Color fundus image
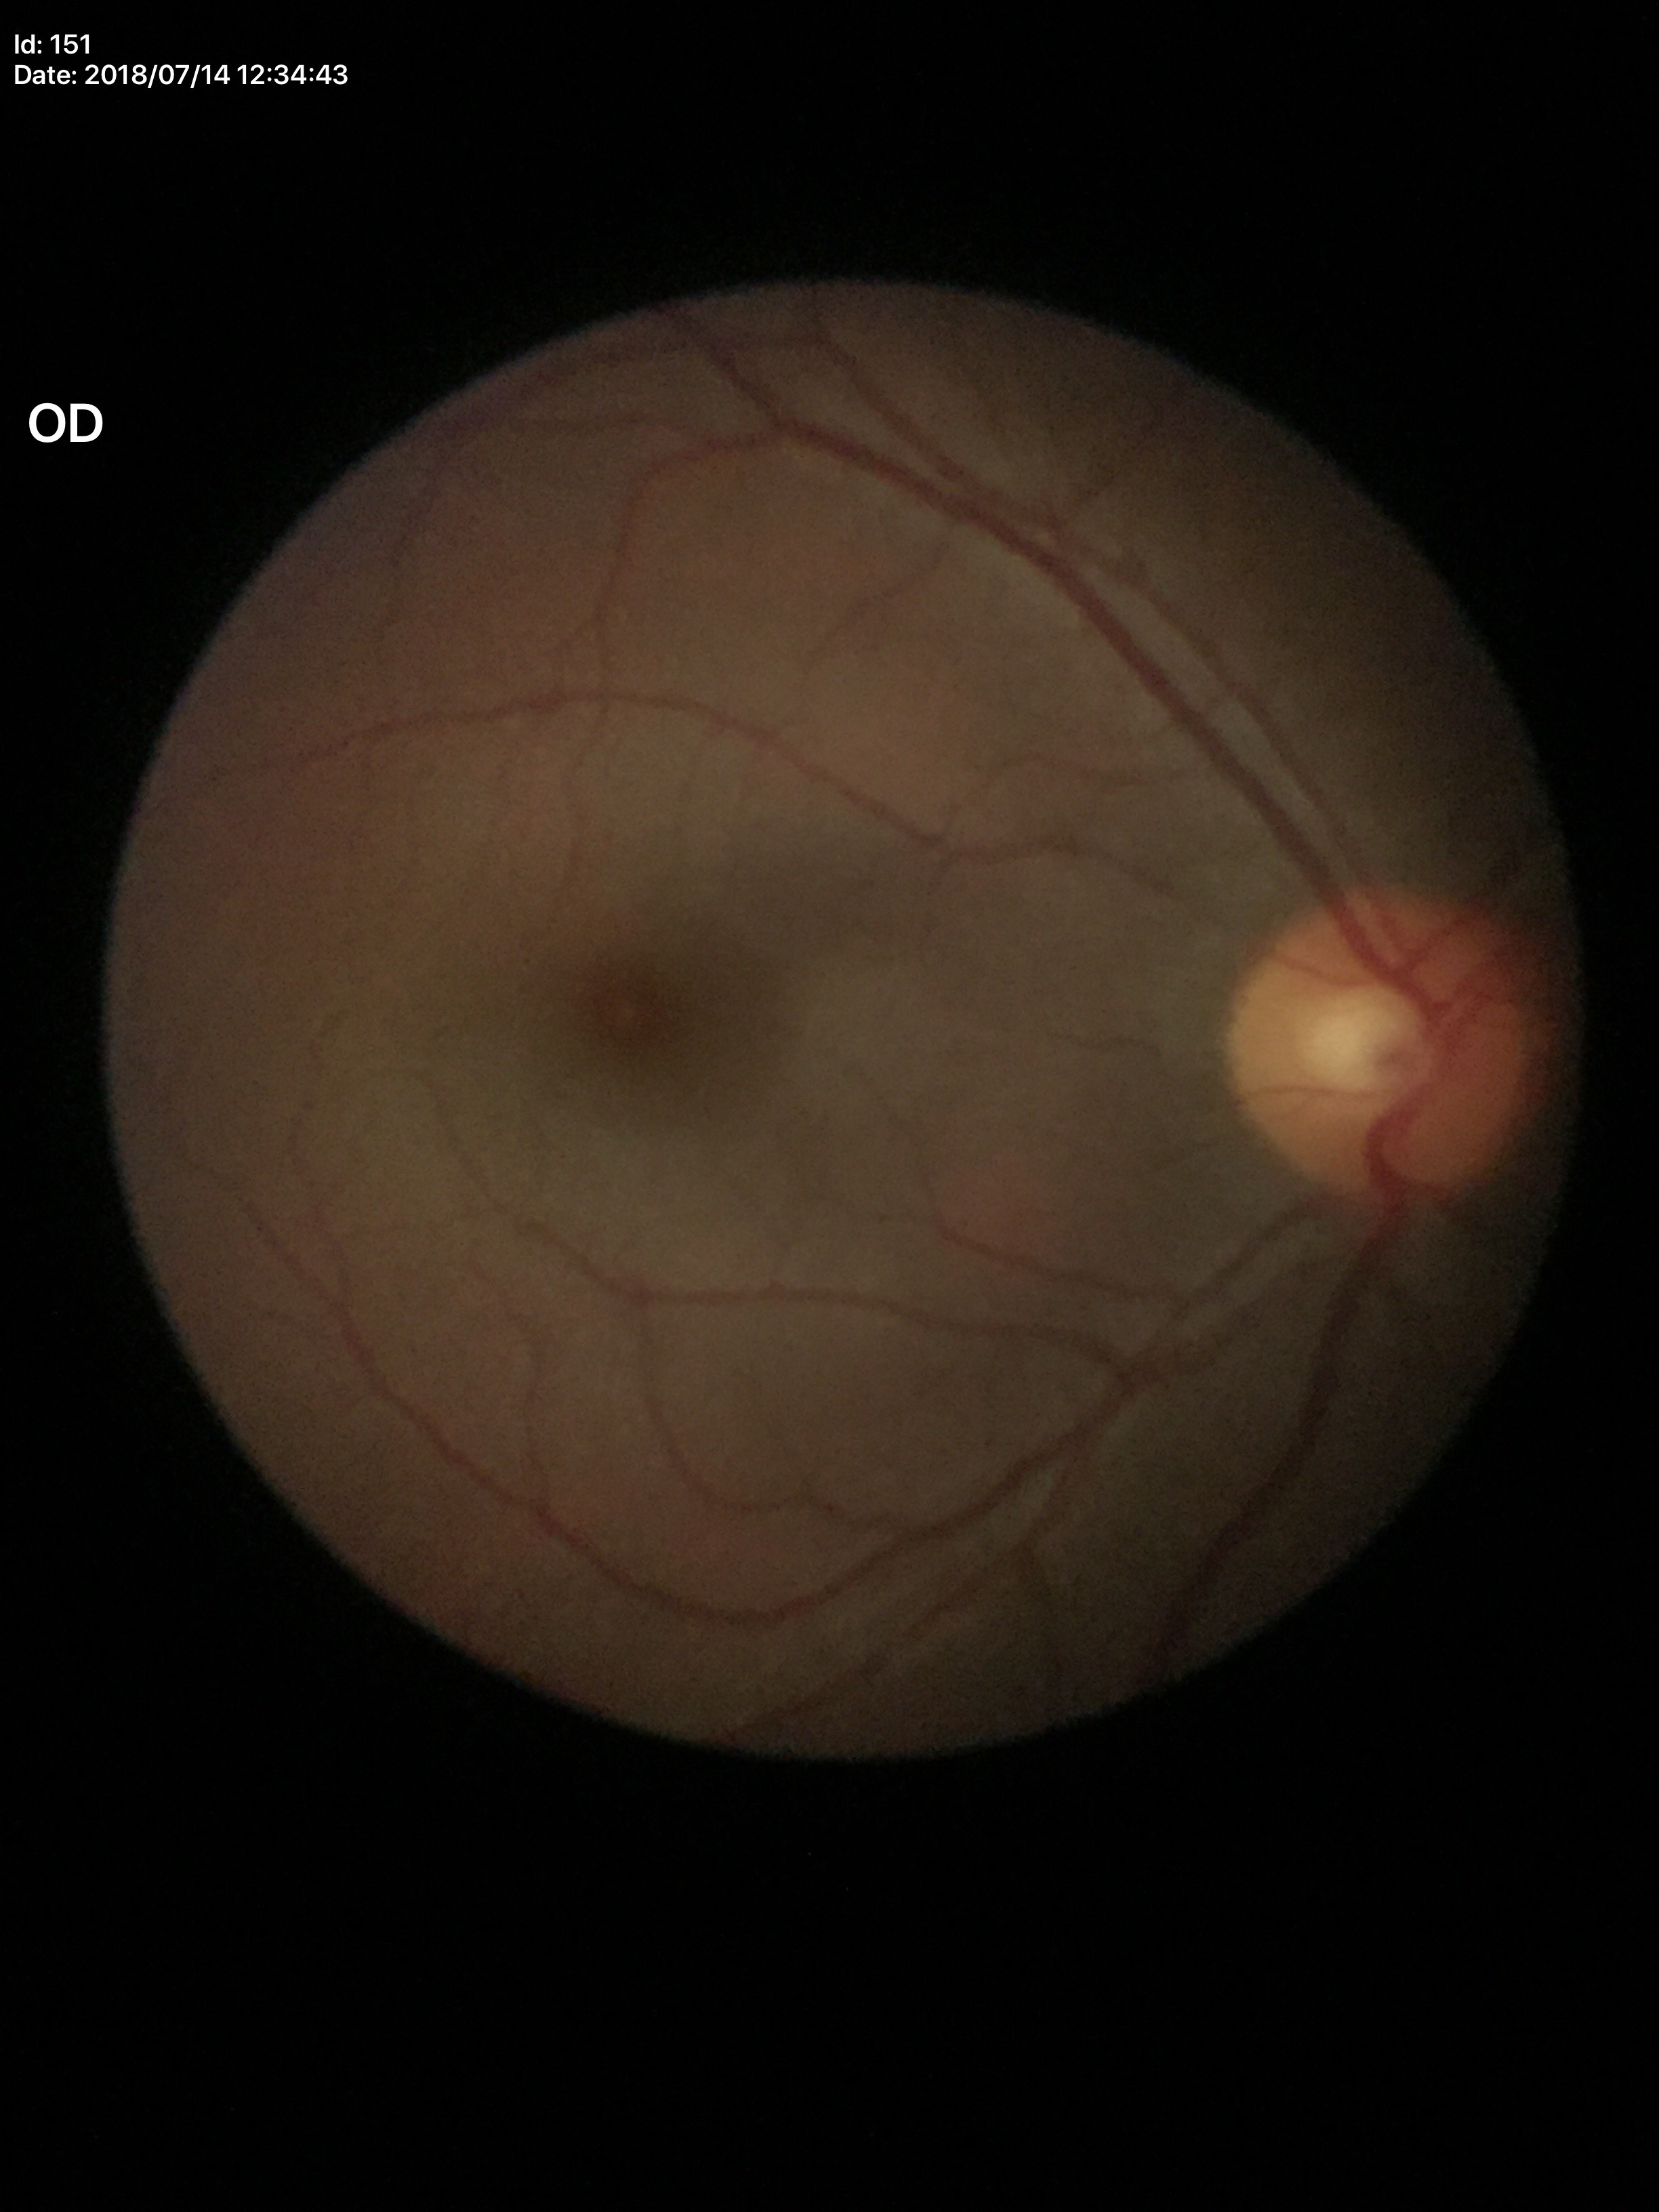

{"vcdr": "0.47", "glaucoma_decision": "negative"}